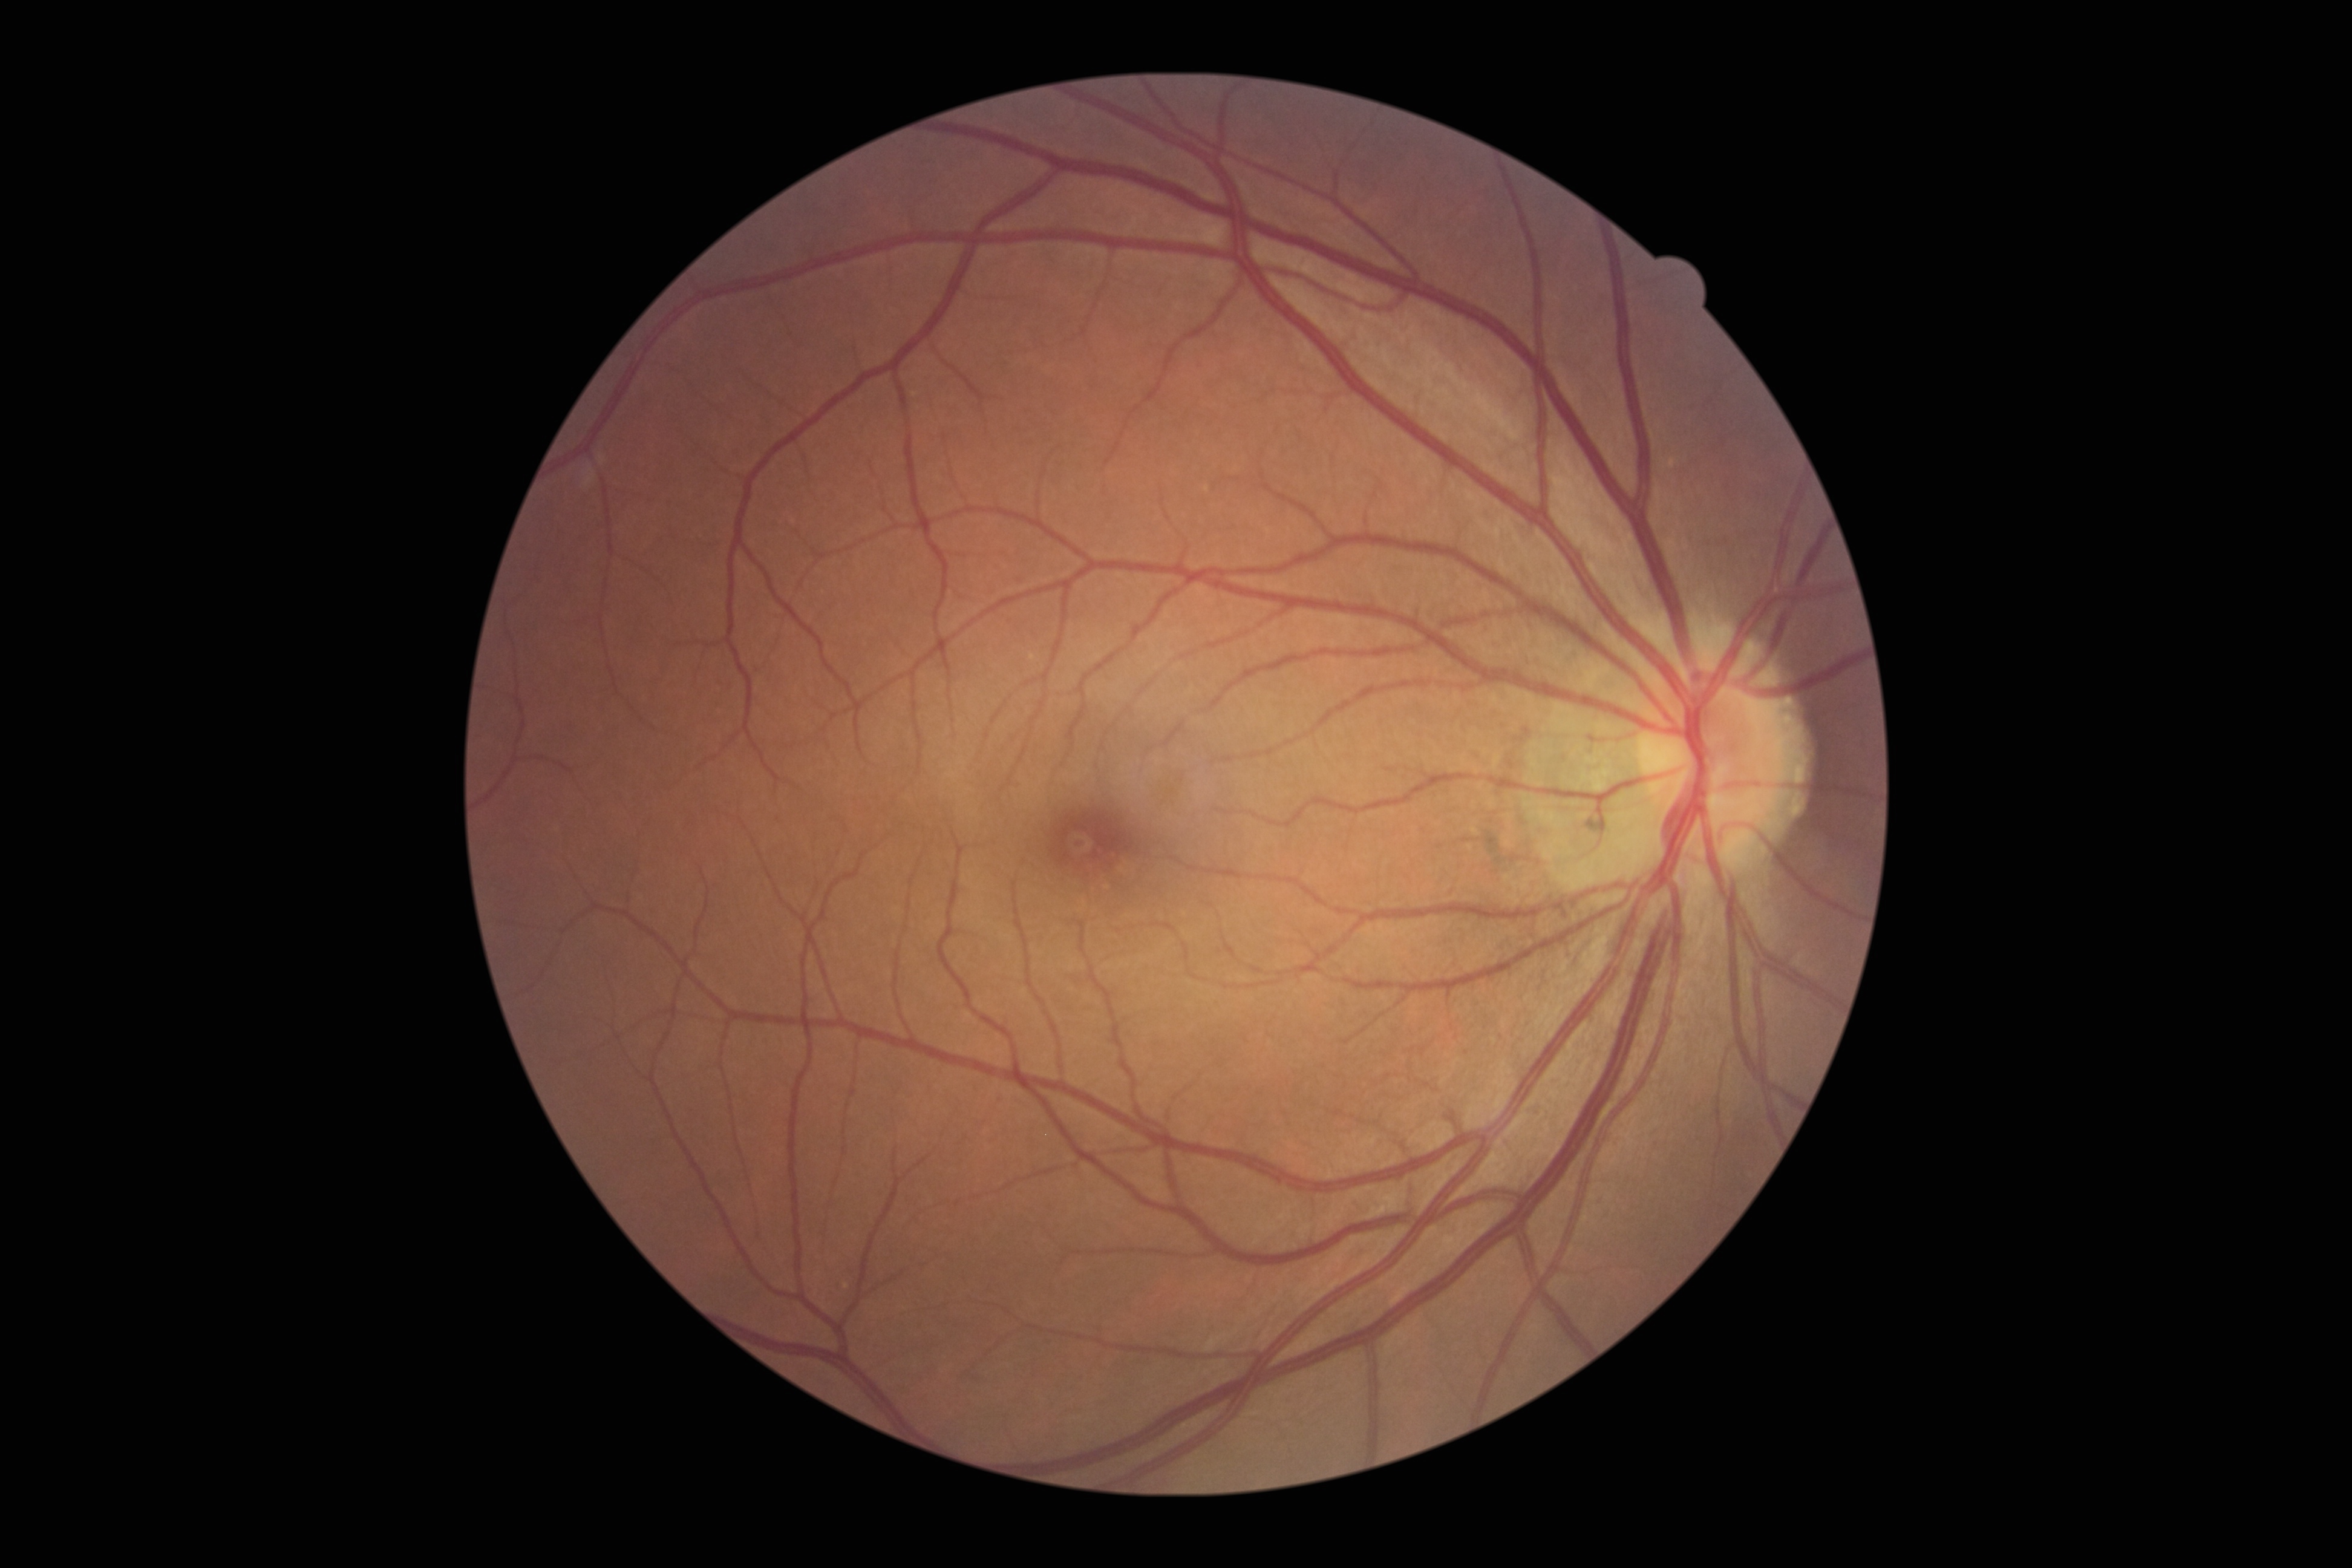

Diabetic retinopathy (DR): grade 0. No diabetic retinal disease findings.